Infant wide-field fundus photograph:
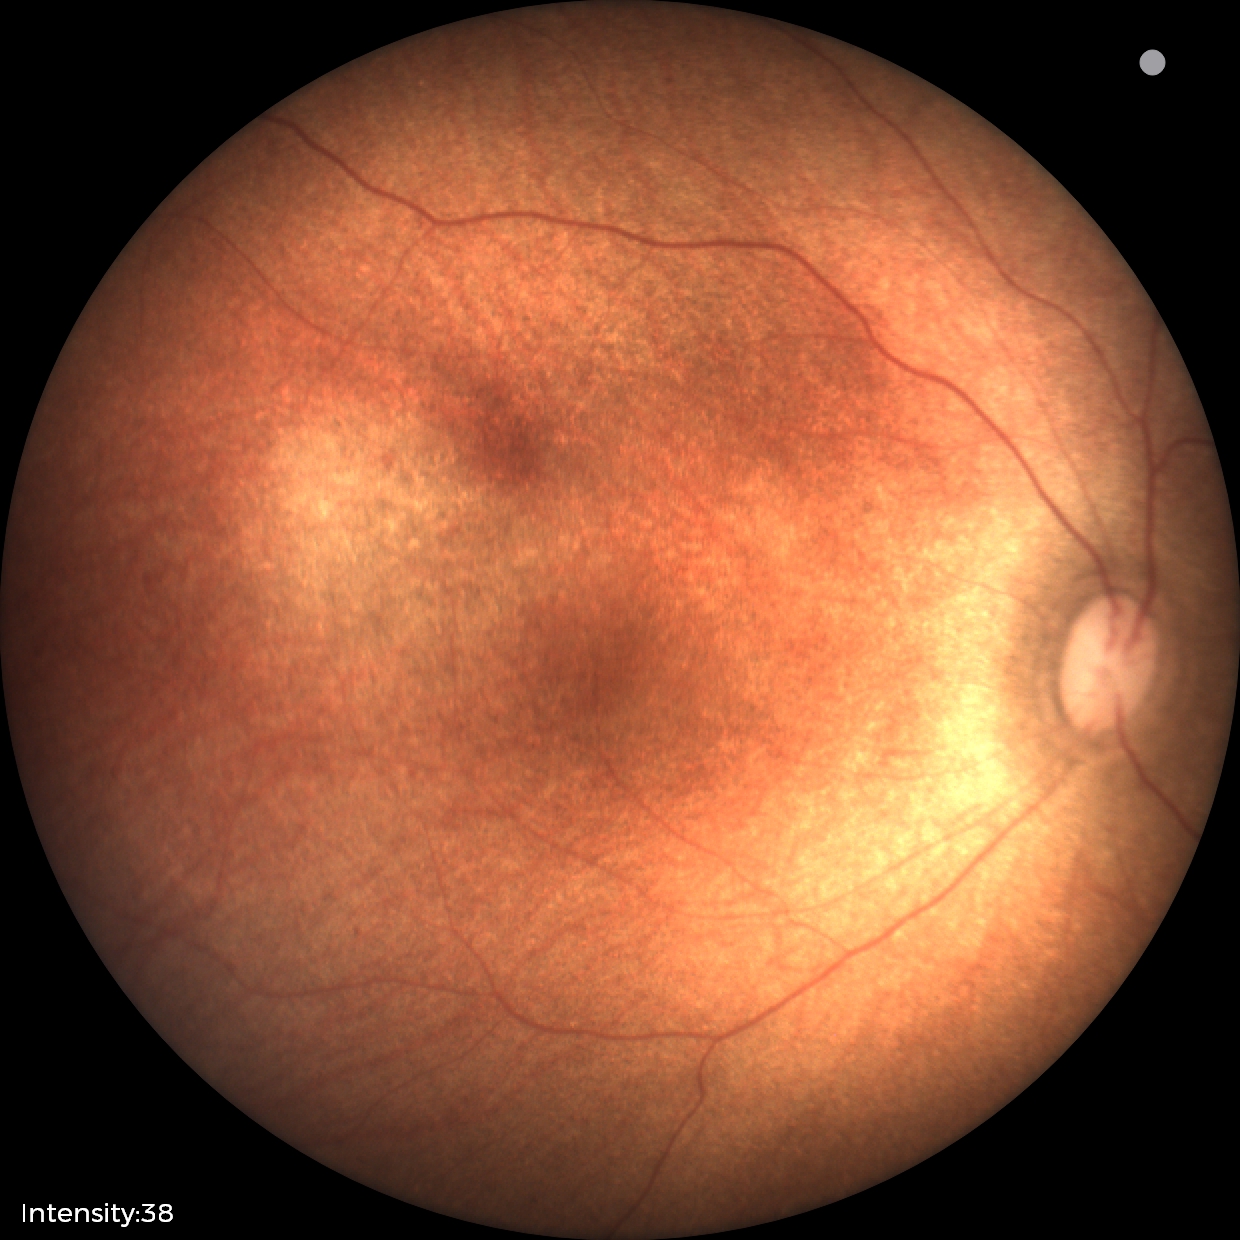
Screening examination diagnosed as physiological.